Fundus photo · 45-degree field of view · diabetic retinopathy graded by the modified Davis classification — 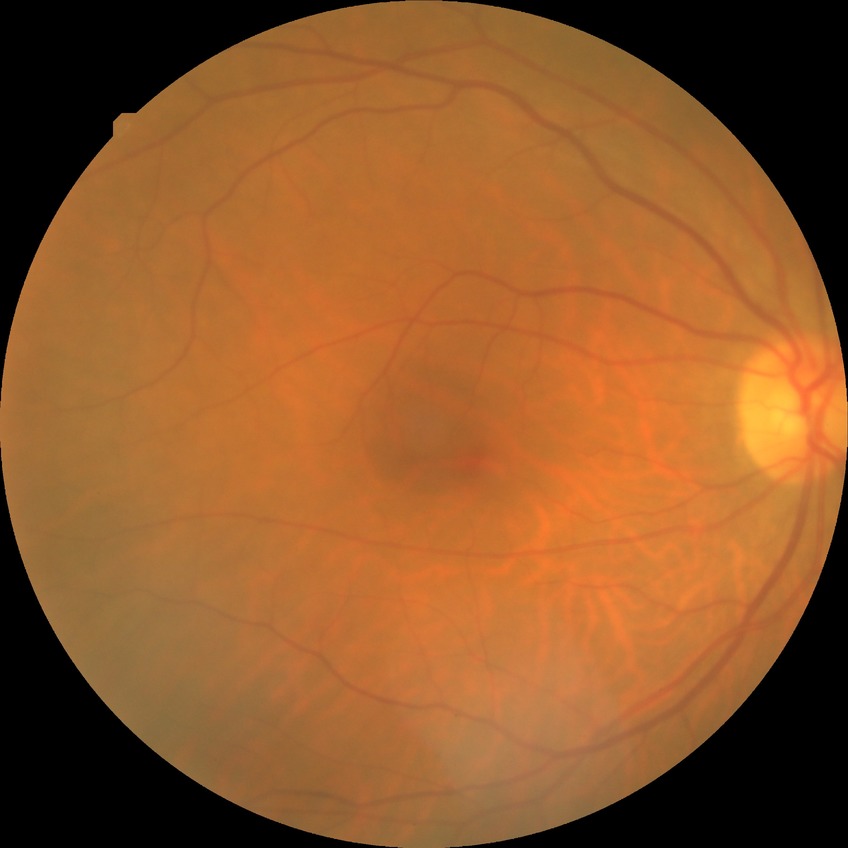 Diabetic retinopathy (DR) is NDR (no diabetic retinopathy).